1932x1932px:
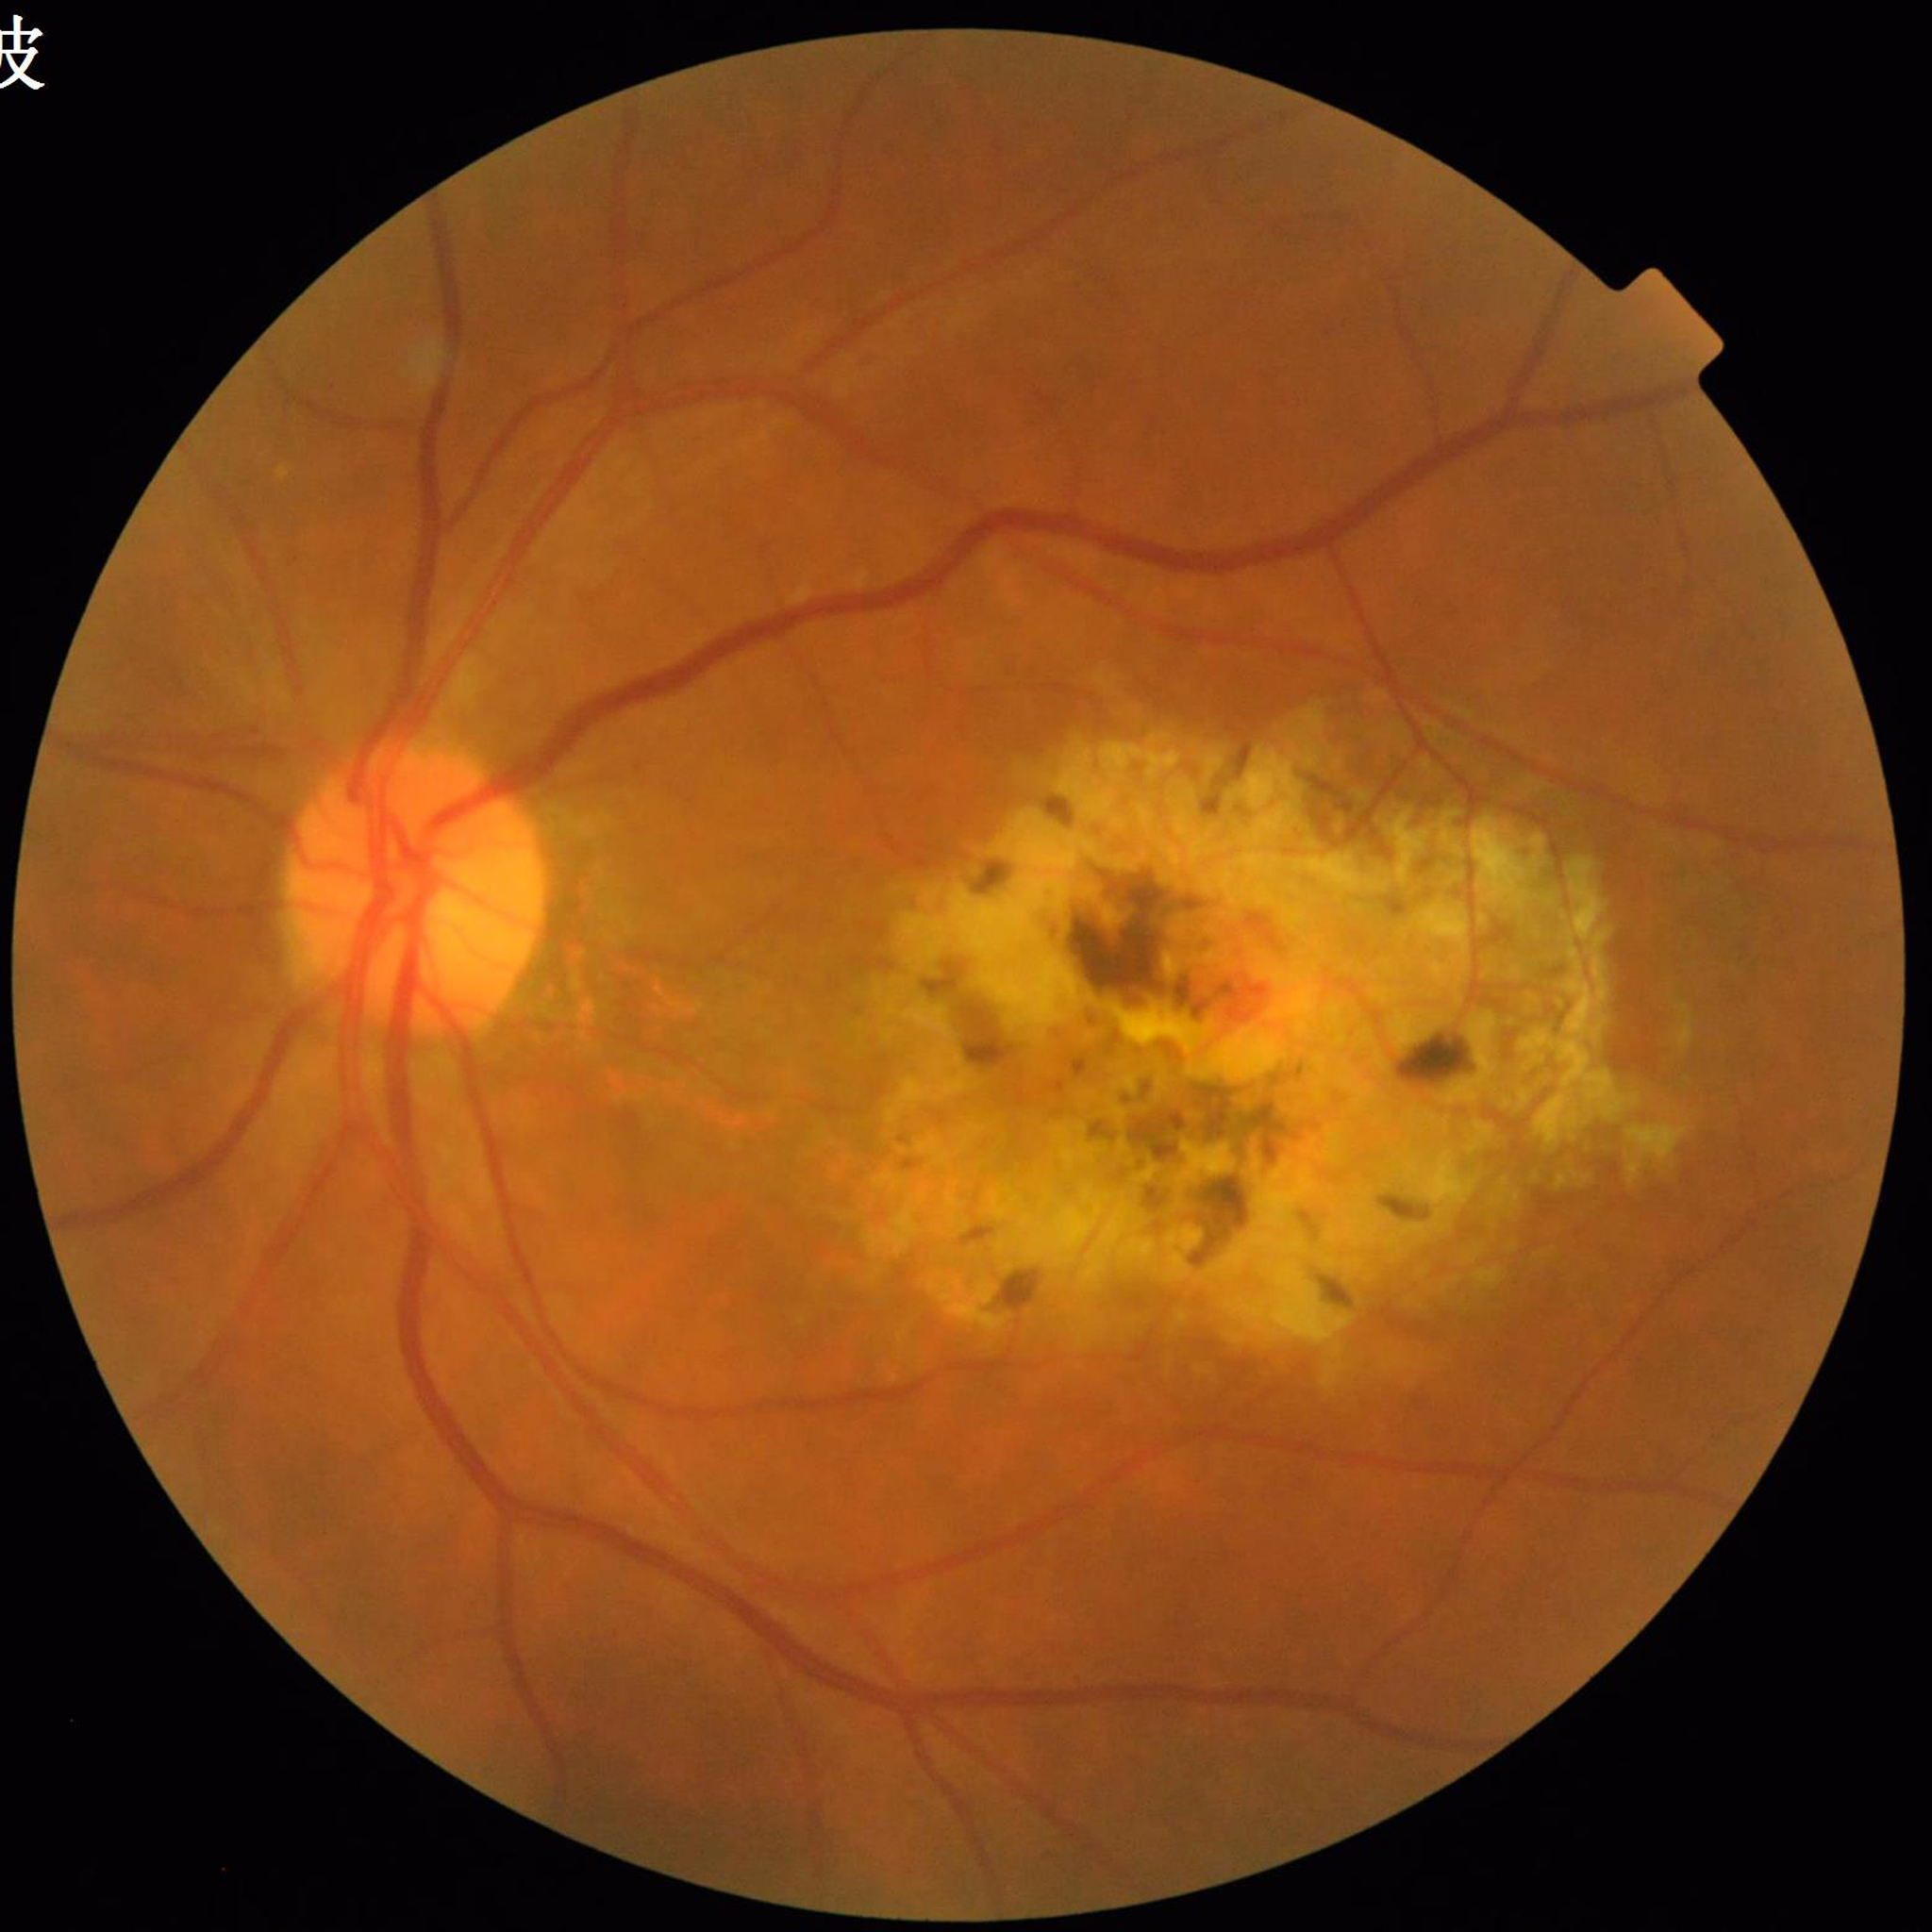
Diagnosis: age-related macular degeneration